Image size 848x848:
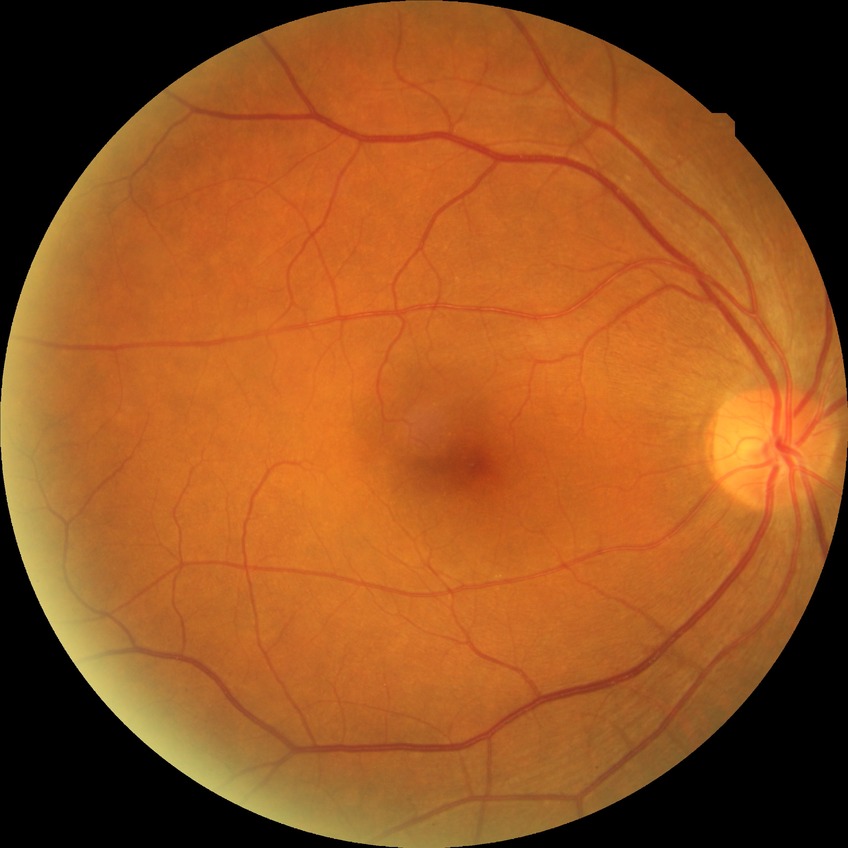

  davis_grade: no diabetic retinopathy